100° field of view (Phoenix ICON); image size 1240x1240; wide-field fundus image from infant ROP screening
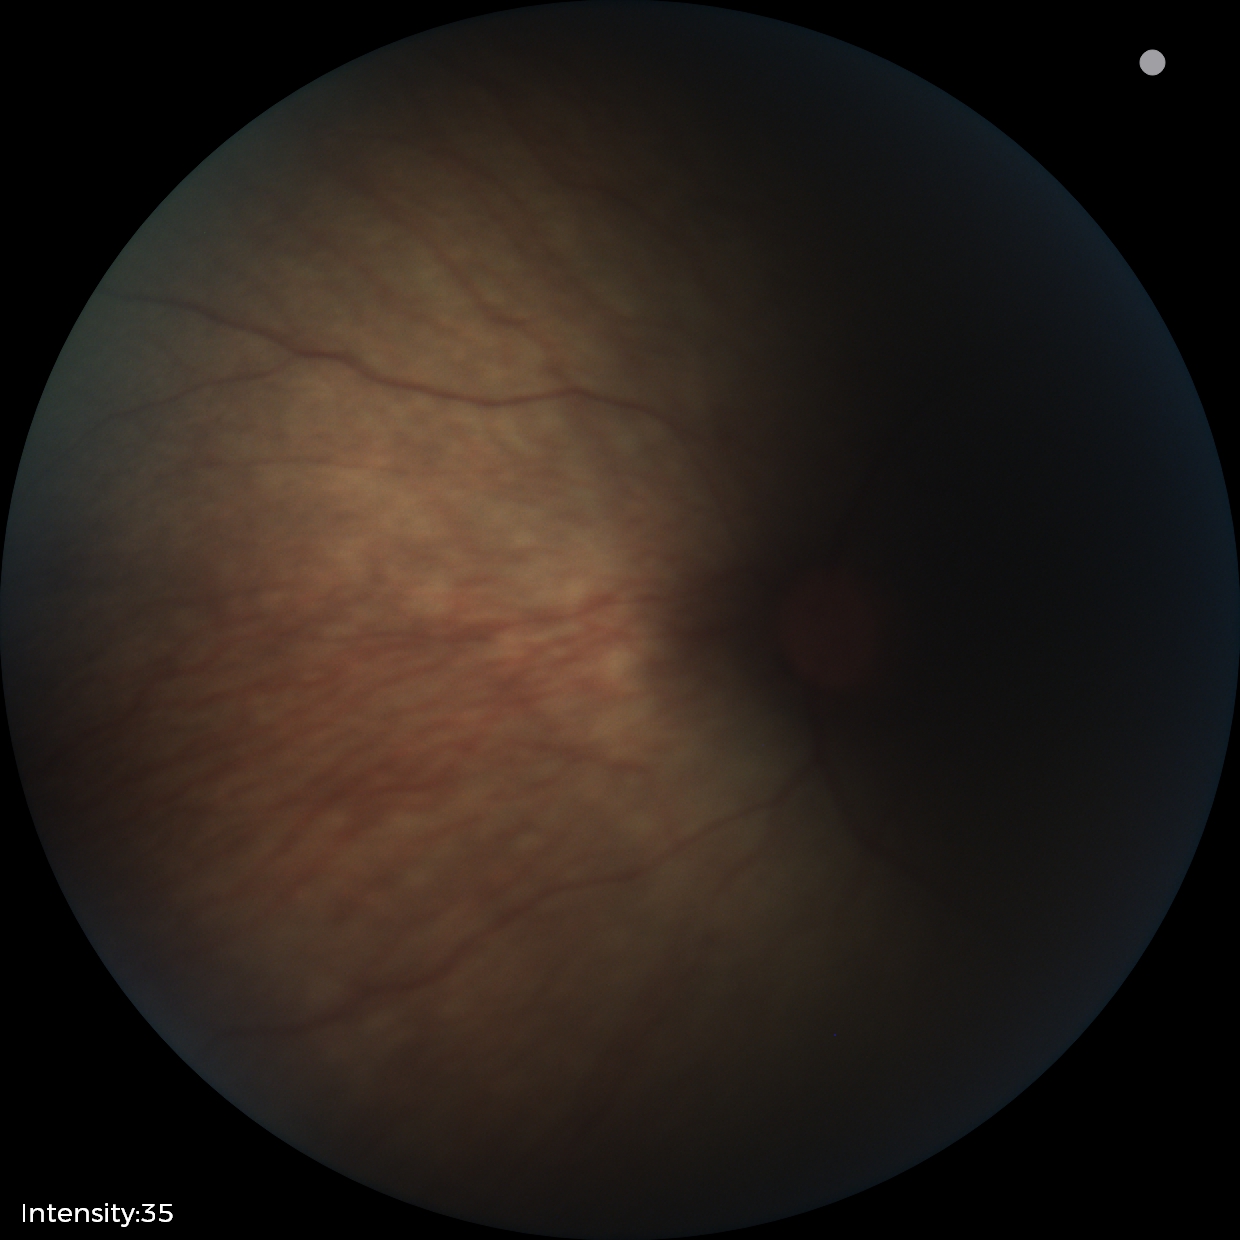

Screening examination with no abnormal retinal findings.